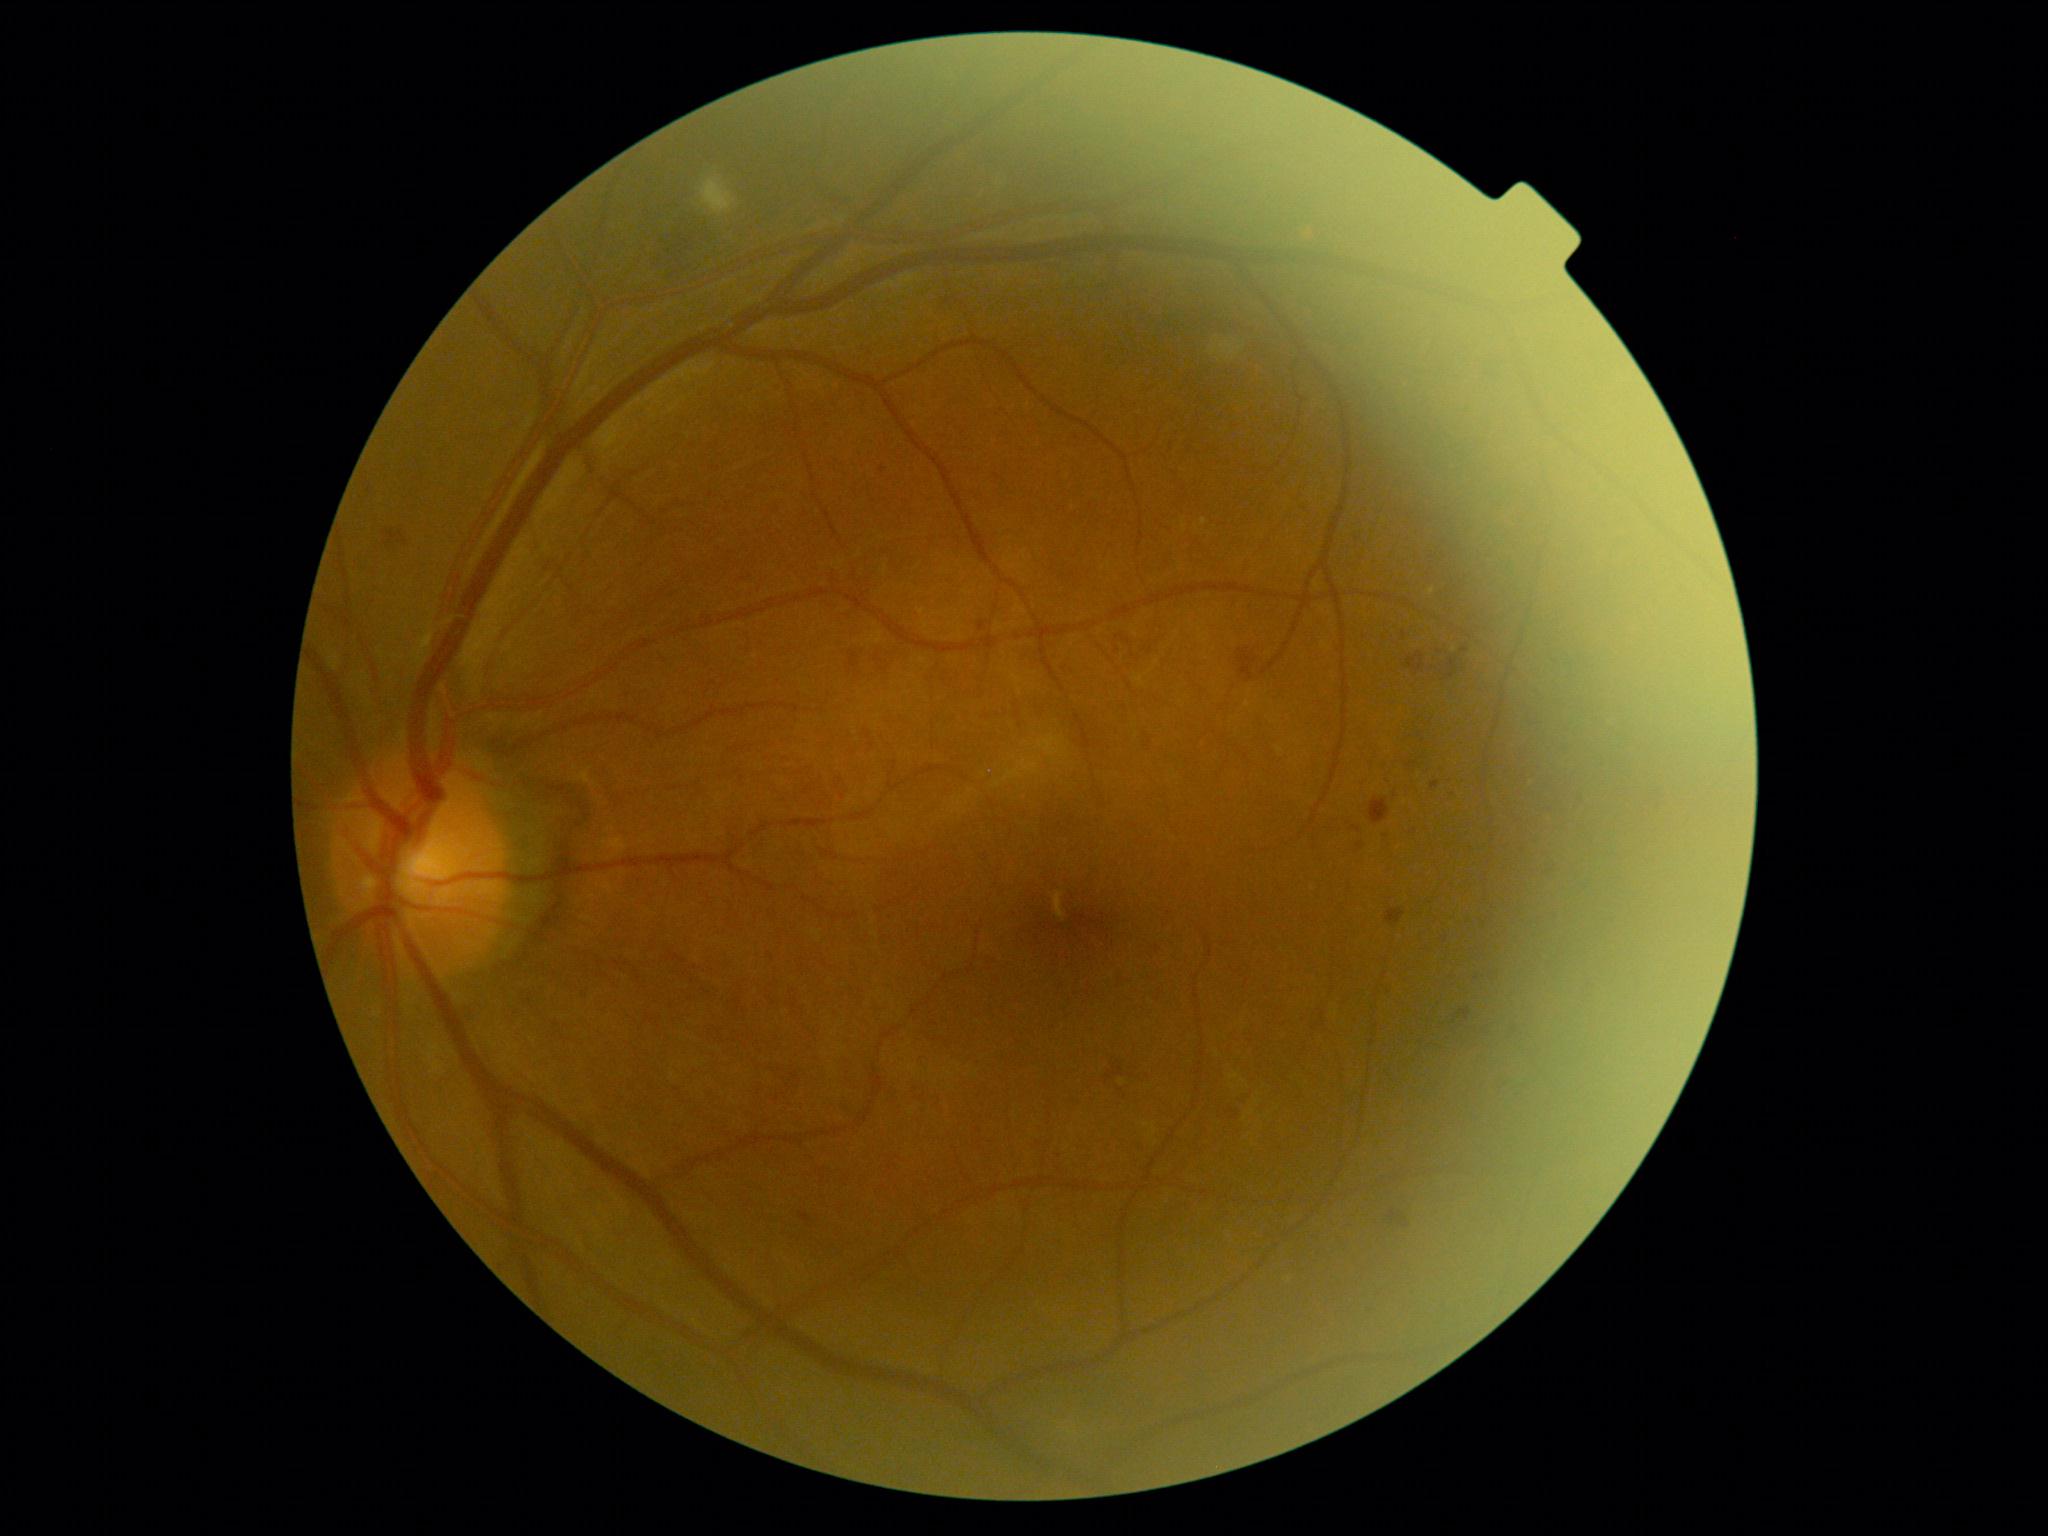 Diabetic retinopathy is moderate non-proliferative diabetic retinopathy (grade 2).